No pharmacologic dilation.
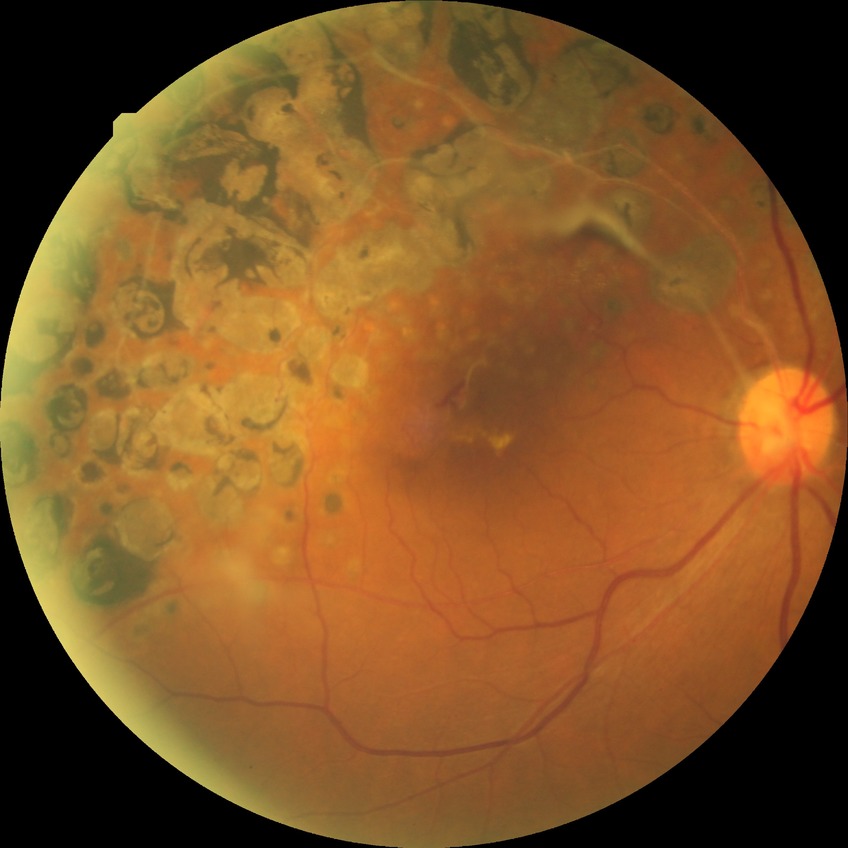

No diabetic retinal disease findings.
Davis DR grade is NDR.